Phoenix ICON wide-field infant fundus image; 1240 x 1240 pixels; camera: Phoenix ICON (100° FOV) — 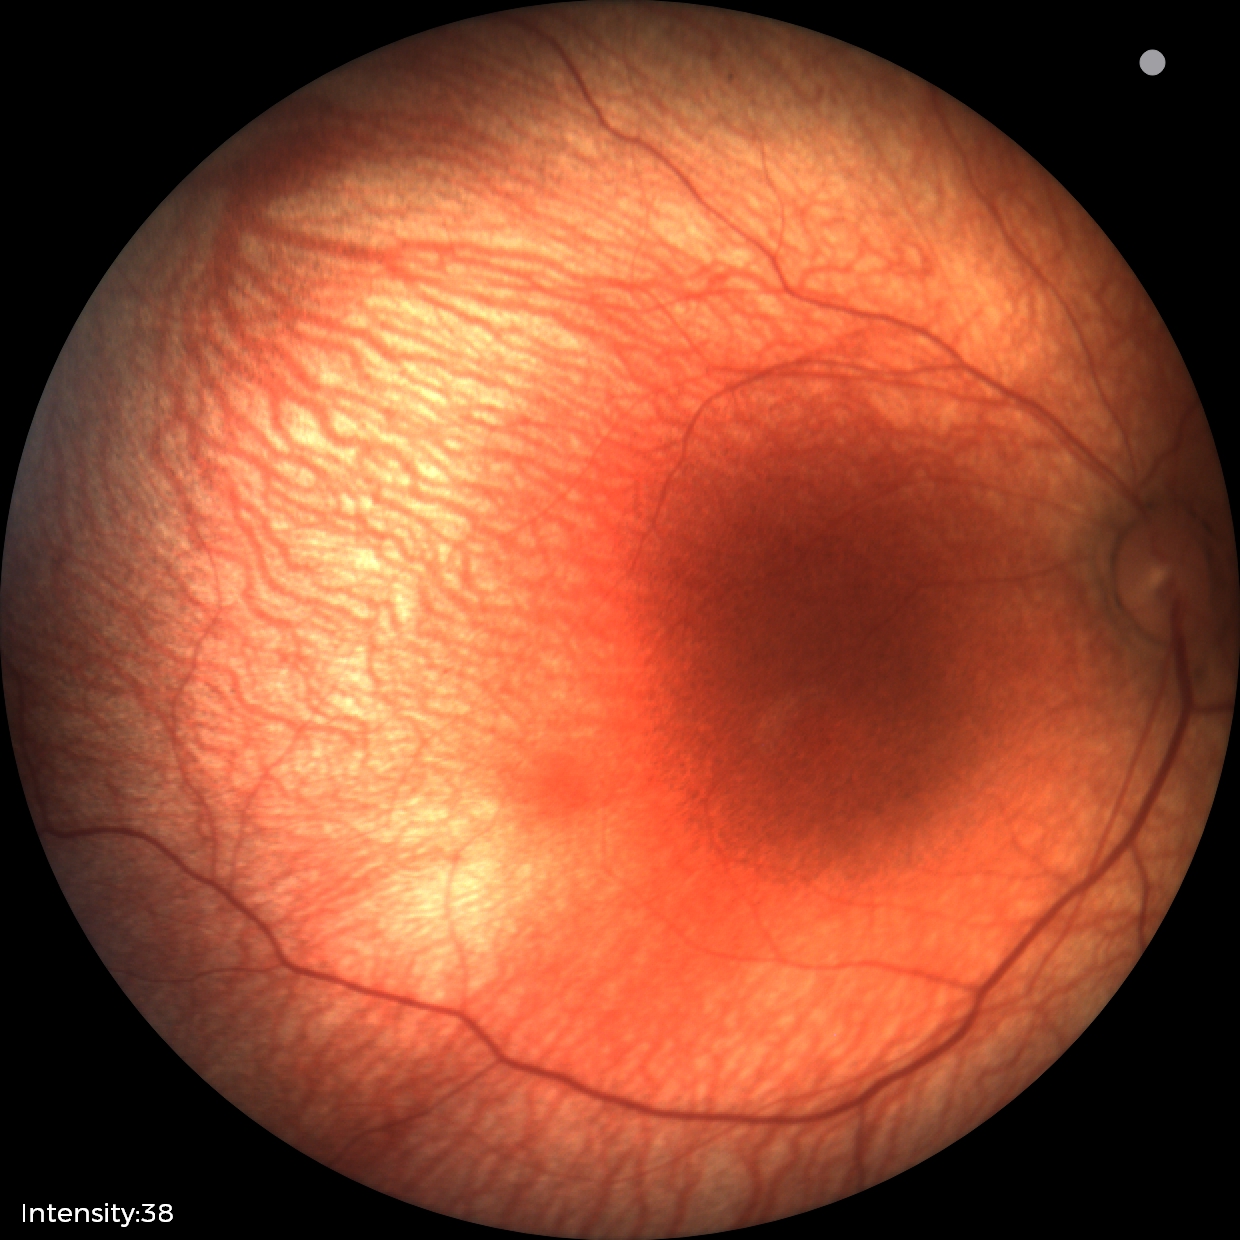
Physiological retinal appearance for postconceptual age.